RetCam wide-field infant fundus image; 130° field of view (Clarity RetCam 3) — 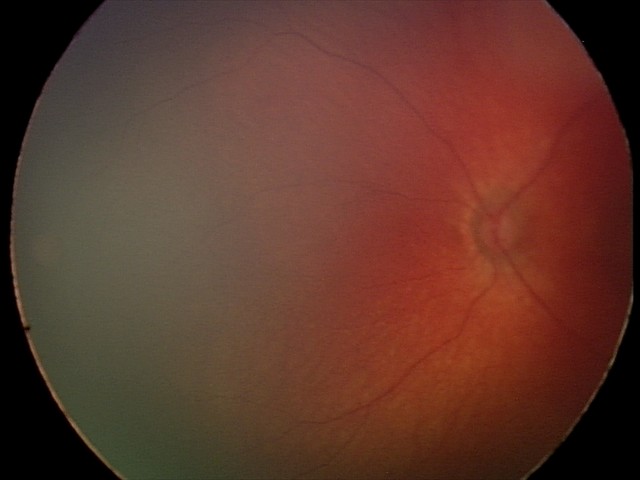 Screening examination consistent with retinal hemorrhages.